848 x 848 pixels — 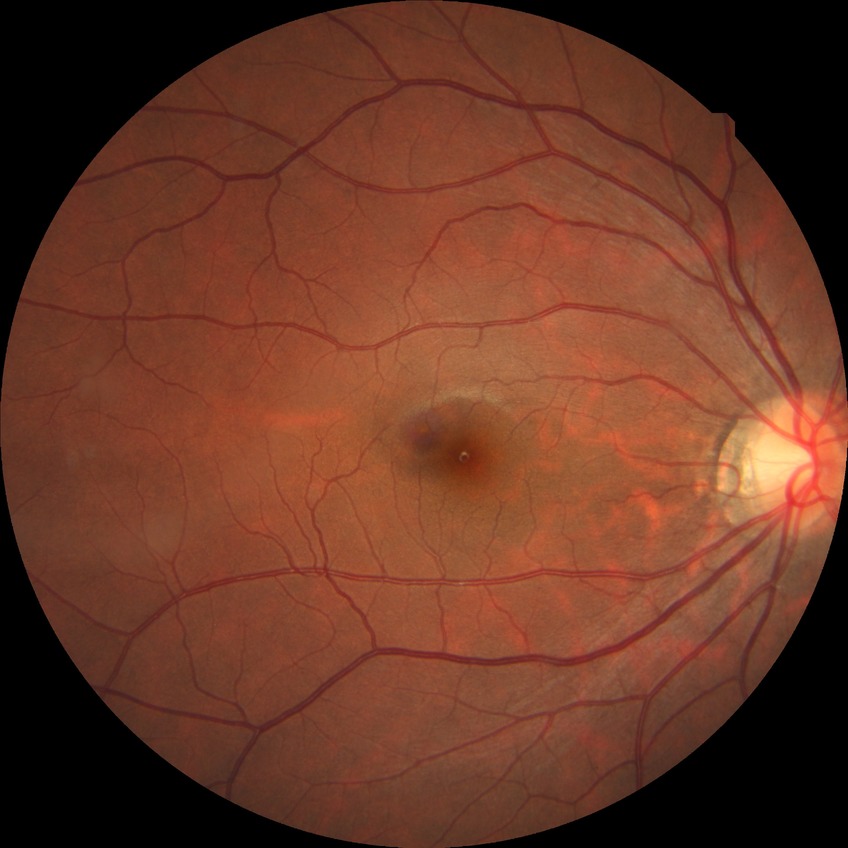 Retinopathy stage: no diabetic retinopathy.